Nonmydriatic · FOV: 45 degrees:
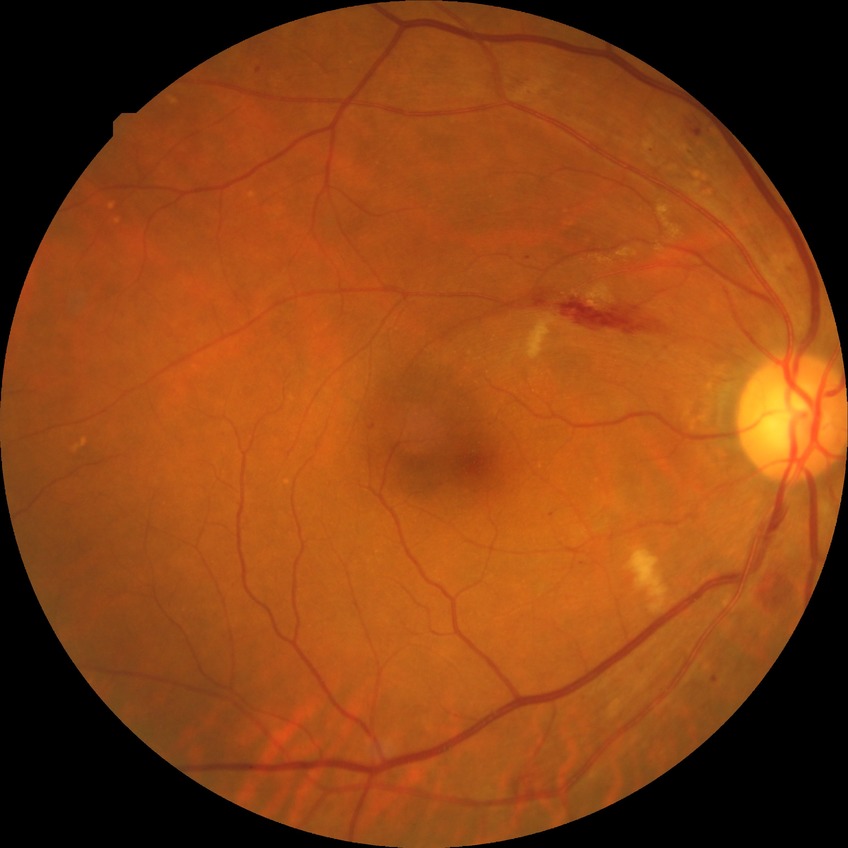 Modified Davis grade is PPDR.